Tabletop color fundus camera image
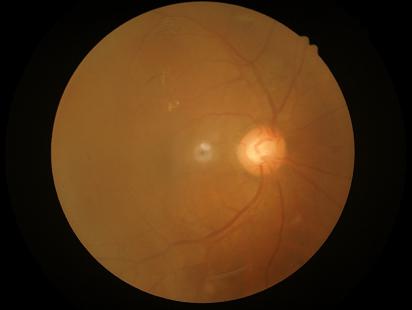 Contrast: good; Overall image quality: poor; Sharpness: reduced.